2352x1568px; fundus photo; 45° FOV.
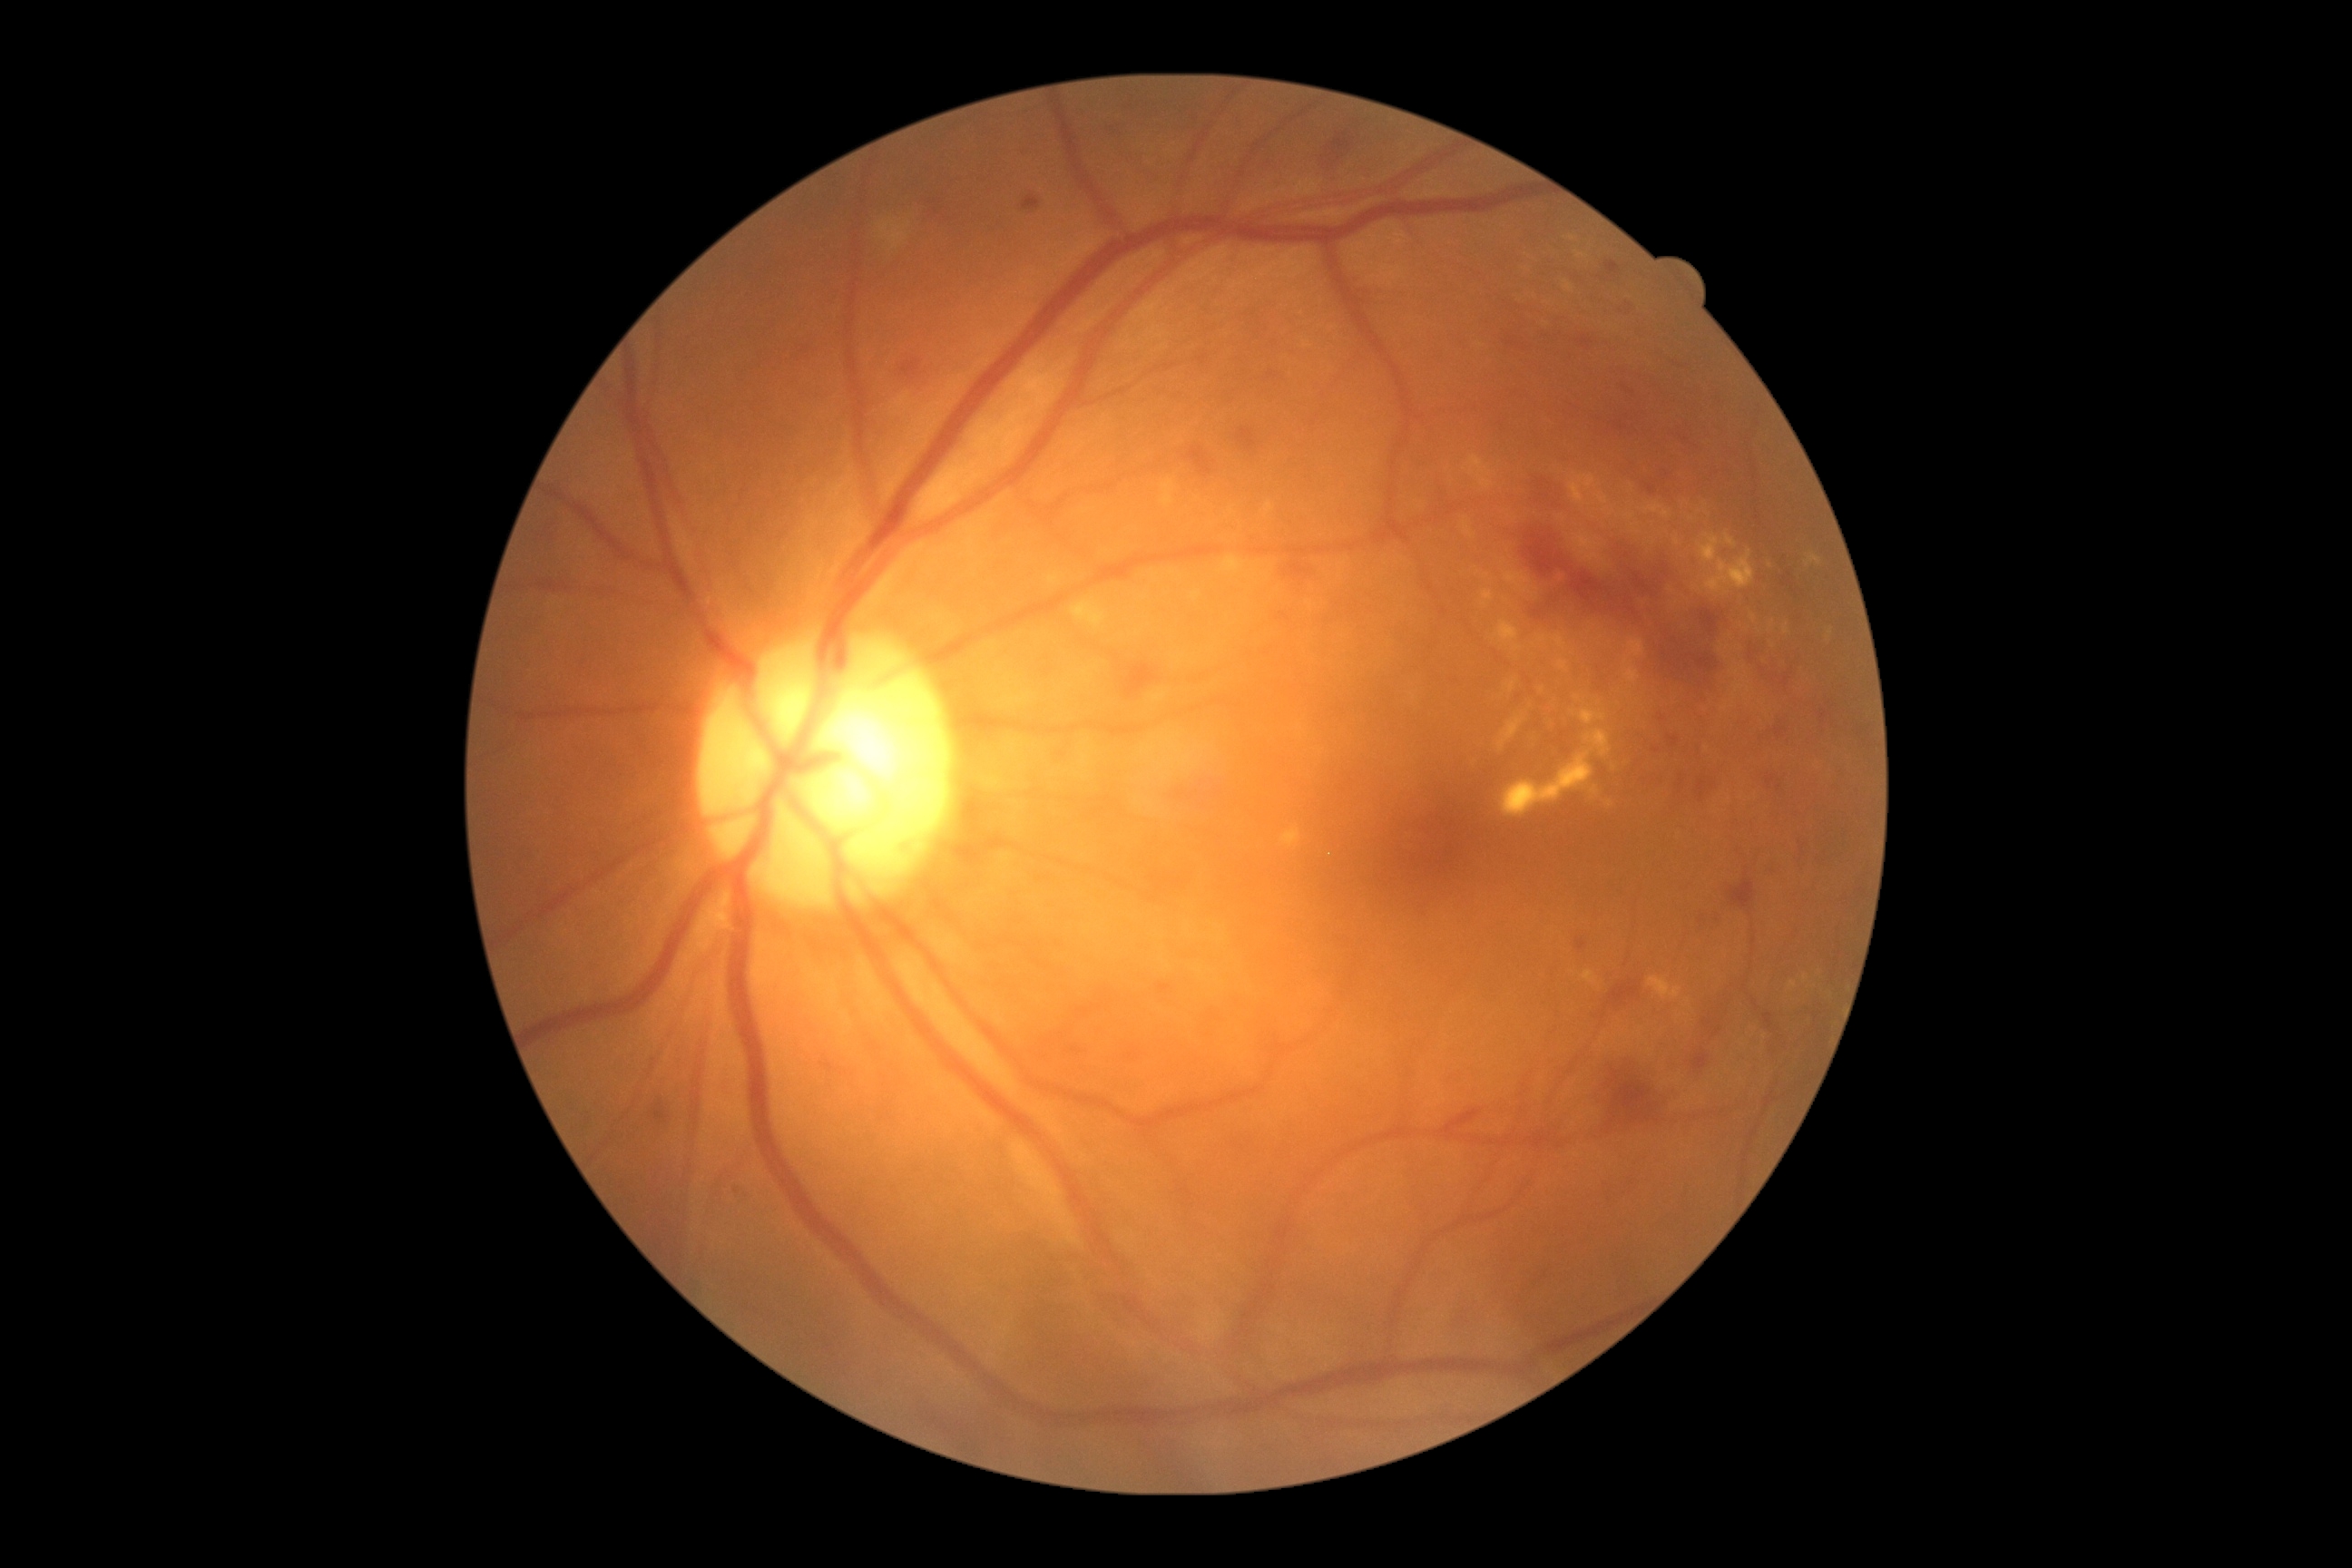

DR grade is 2 (moderate NPDR).
HEs include lesions at (1689,910,1705,926) | (1171,789,1193,799) | (1126,663,1157,700) | (654,1110,667,1121) | (1671,770,1720,810) | (1609,983,1640,1006) | (1591,1046,1667,1130) | (1732,881,1756,908) | (1322,135,1355,179) | (1284,562,1309,578) | (1703,1021,1712,1026).
EXs include lesions at (1632,525,1642,534) | (1266,502,1273,514) | (1563,280,1574,293) | (1783,625,1790,634) | (1580,710,1607,725) | (1280,827,1302,848) | (1585,730,1612,758) | (1509,681,1518,692) | (1625,669,1640,683) | (1805,553,1823,567) | (1705,551,1756,593) | (1072,602,1108,629) | (1494,622,1524,651) | (1464,522,1475,538).
Small EXs near 1609/804 | 1765/1037 | 1745/679 | 1573/238 | 1578/698 | 1487/575.
MAs include lesions at (1669,736,1680,747) | (1767,776,1776,789) | (901,358,921,378) | (1607,262,1620,275) | (1578,335,1594,349) | (1821,710,1828,723).
Small MAs near 1686/440 | 1214/1018 | 1079/1012 | 1663/719 | 1086/1012 | 736/1190.